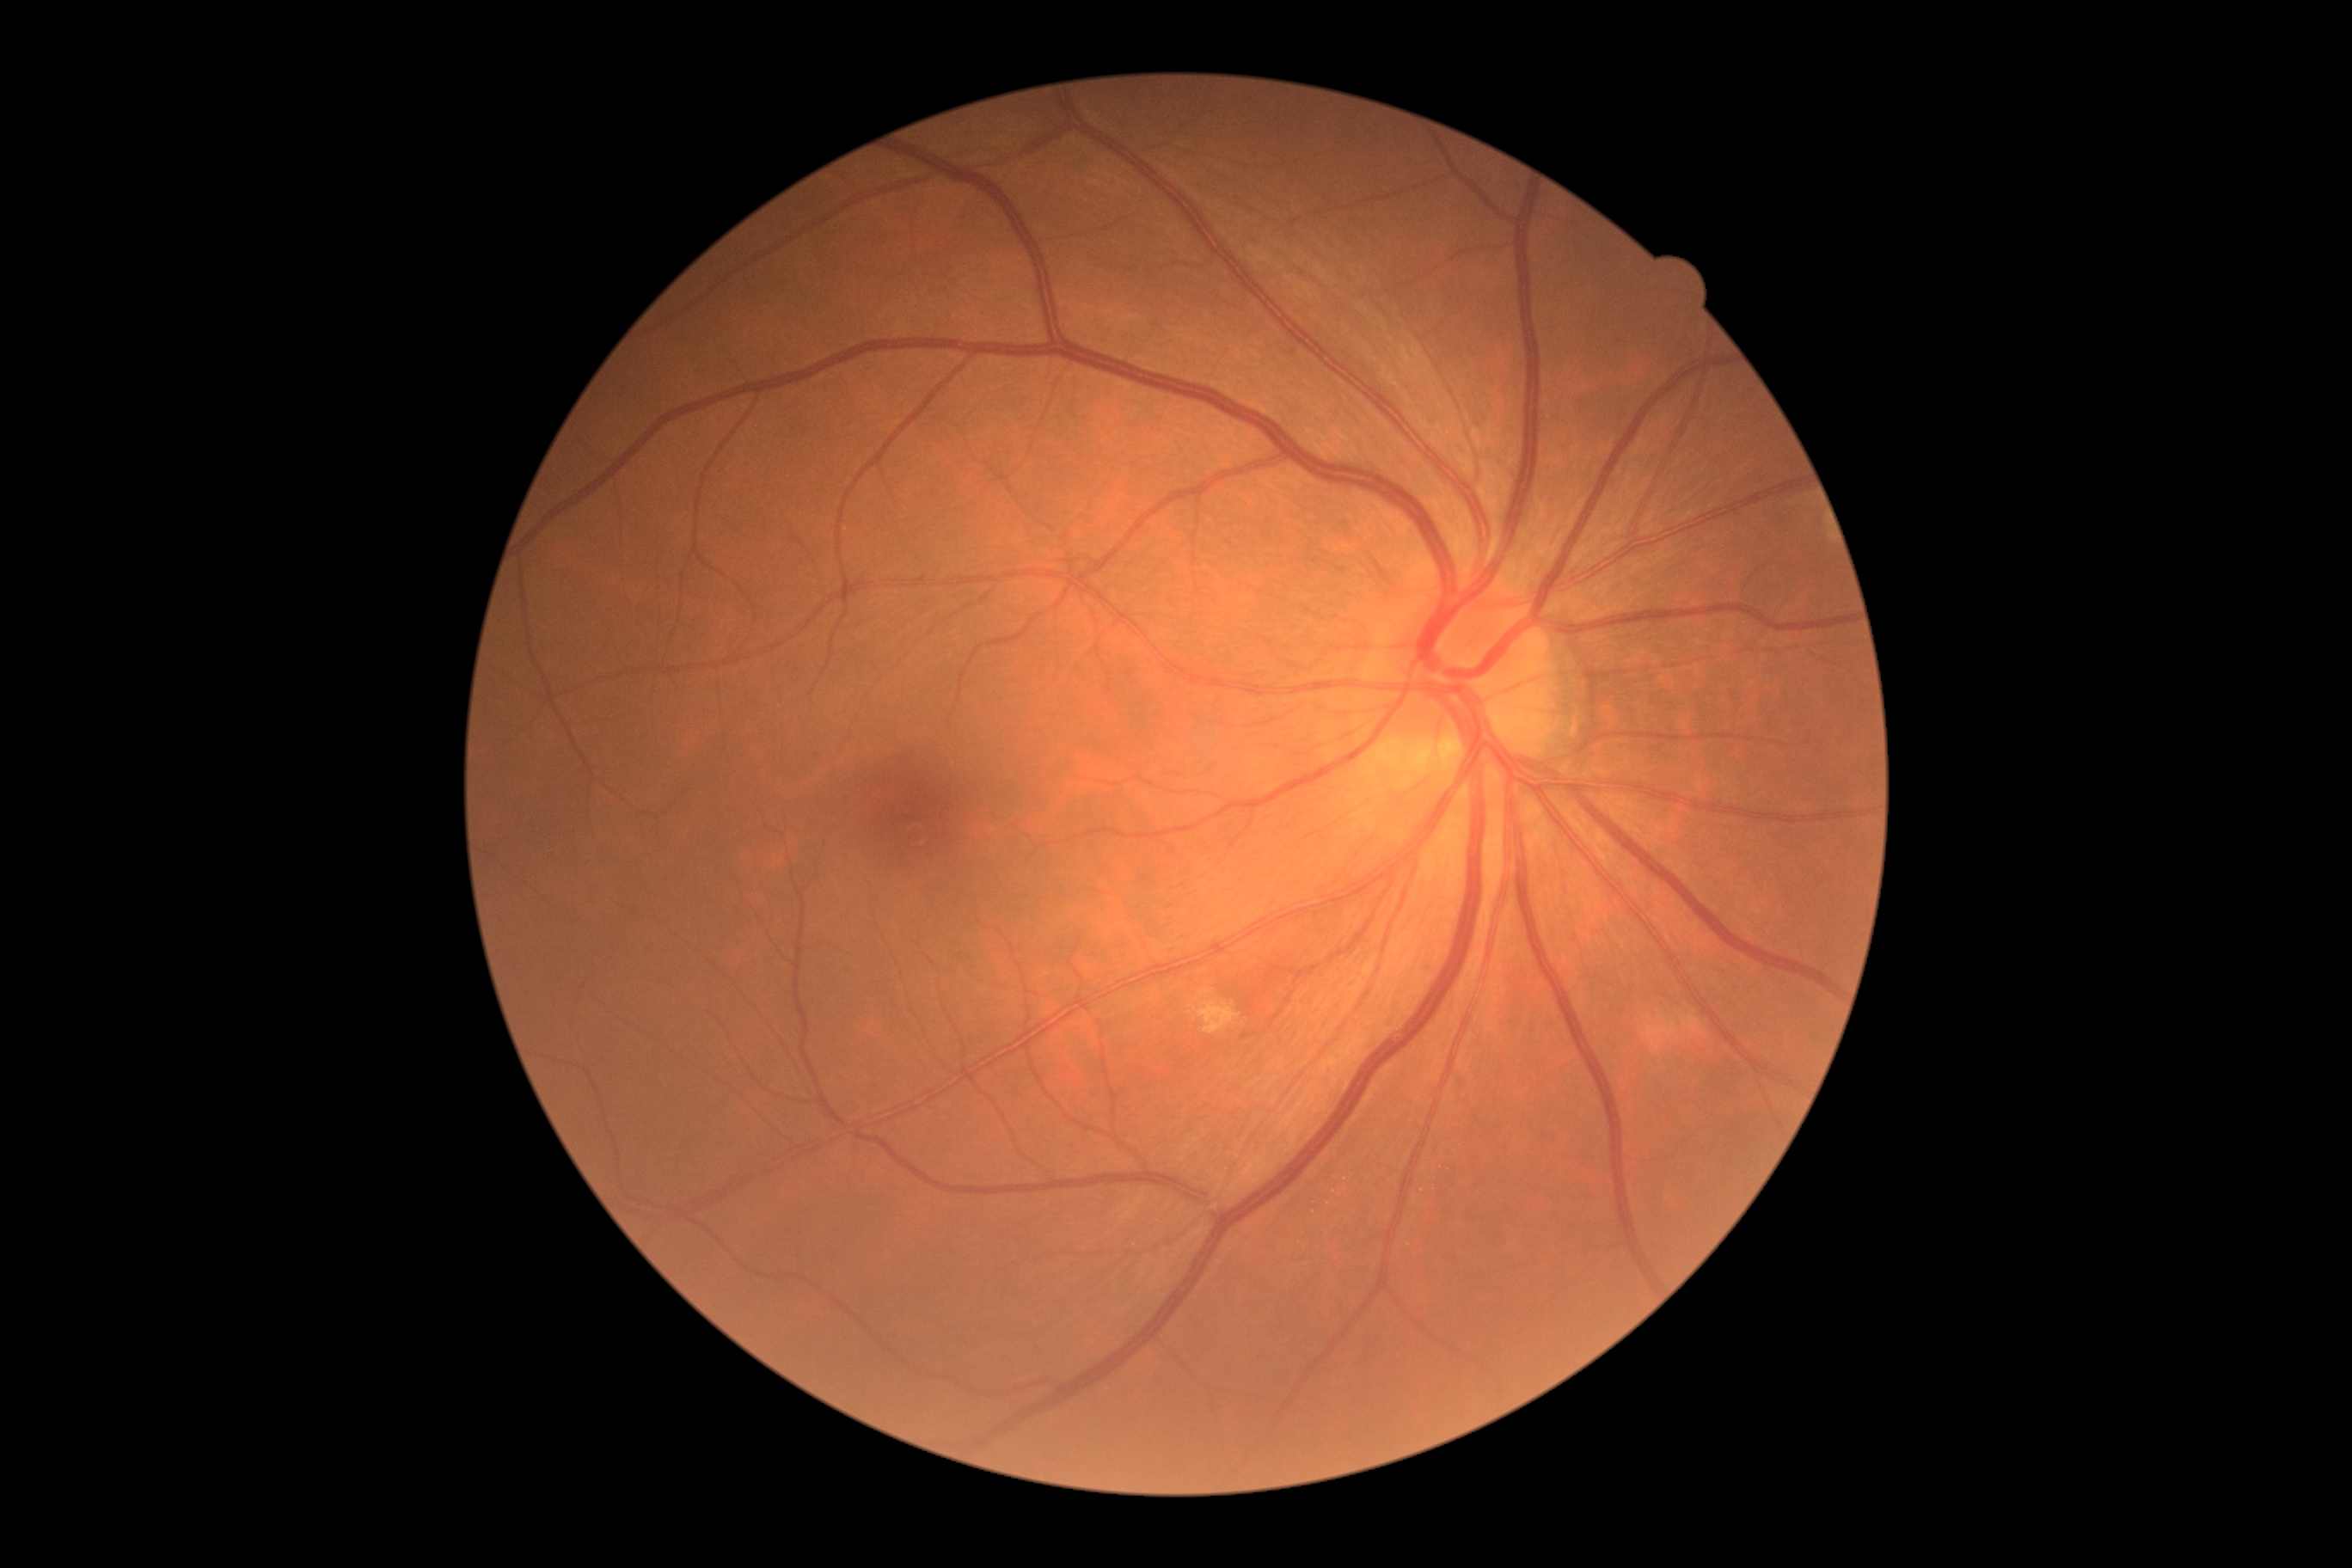 Diabetic retinopathy (DR) is grade 2 (moderate NPDR).